Pediatric retinal photograph (wide-field); image size 1240x1240
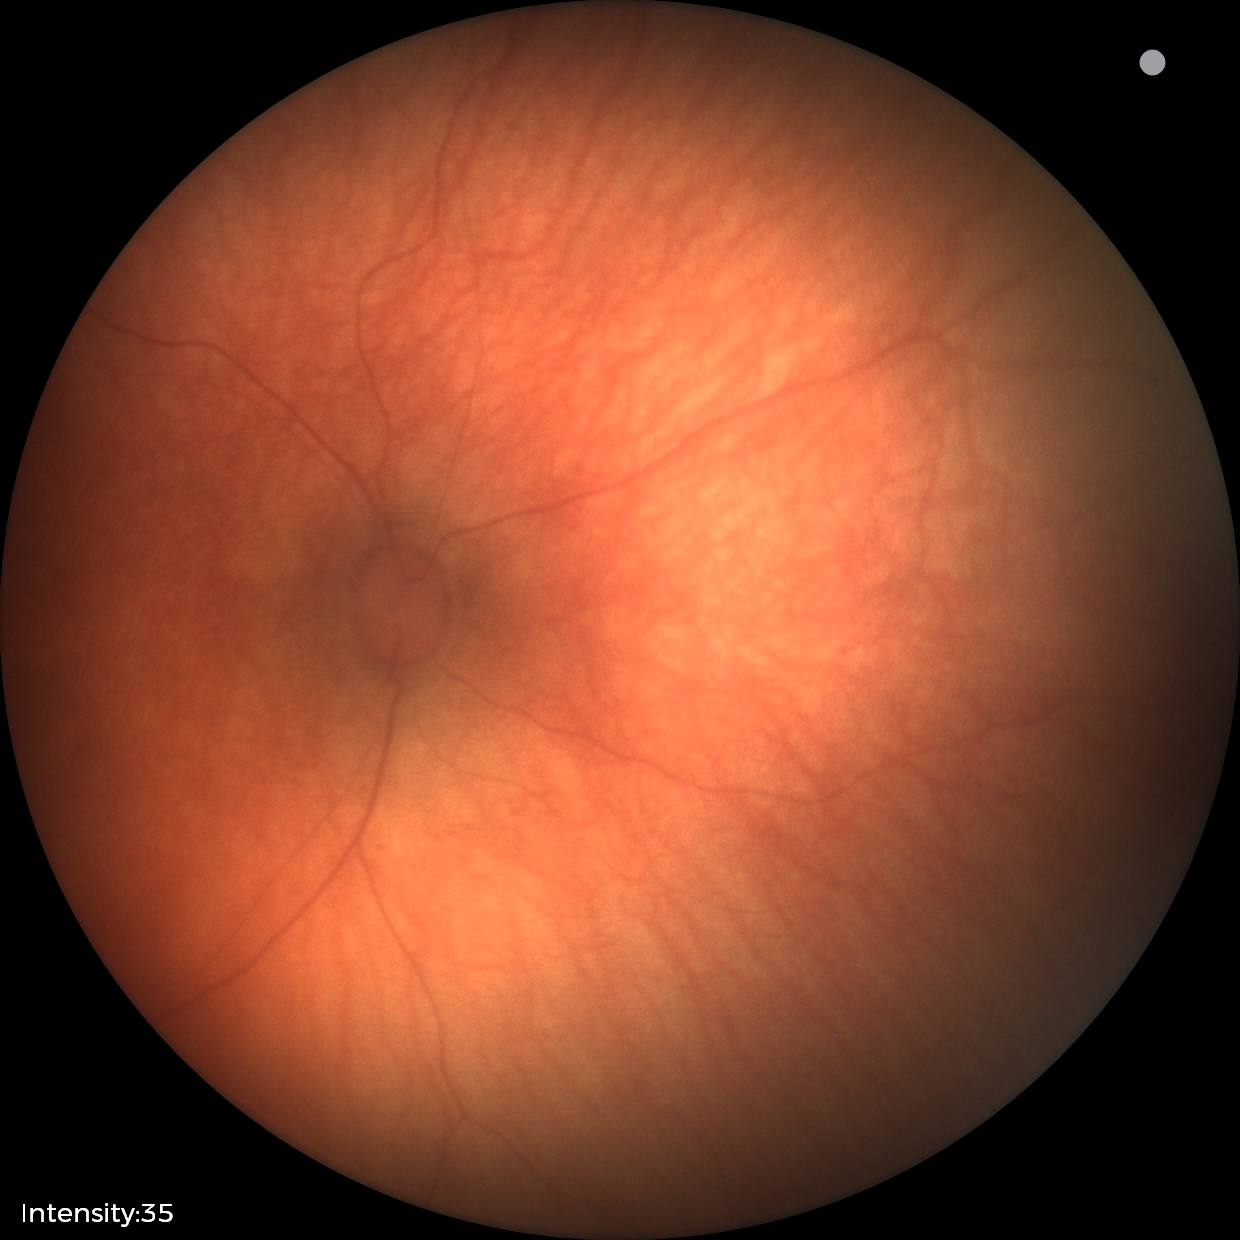 Examination with physiological retinal findings.